Topcon TRC-NW400. 2212x1661. Patient age: 74 years. Central corneal thickness: 583 µm. Optic disc at the center of the field. FOV: 30 degrees. Retinal fundus photograph:
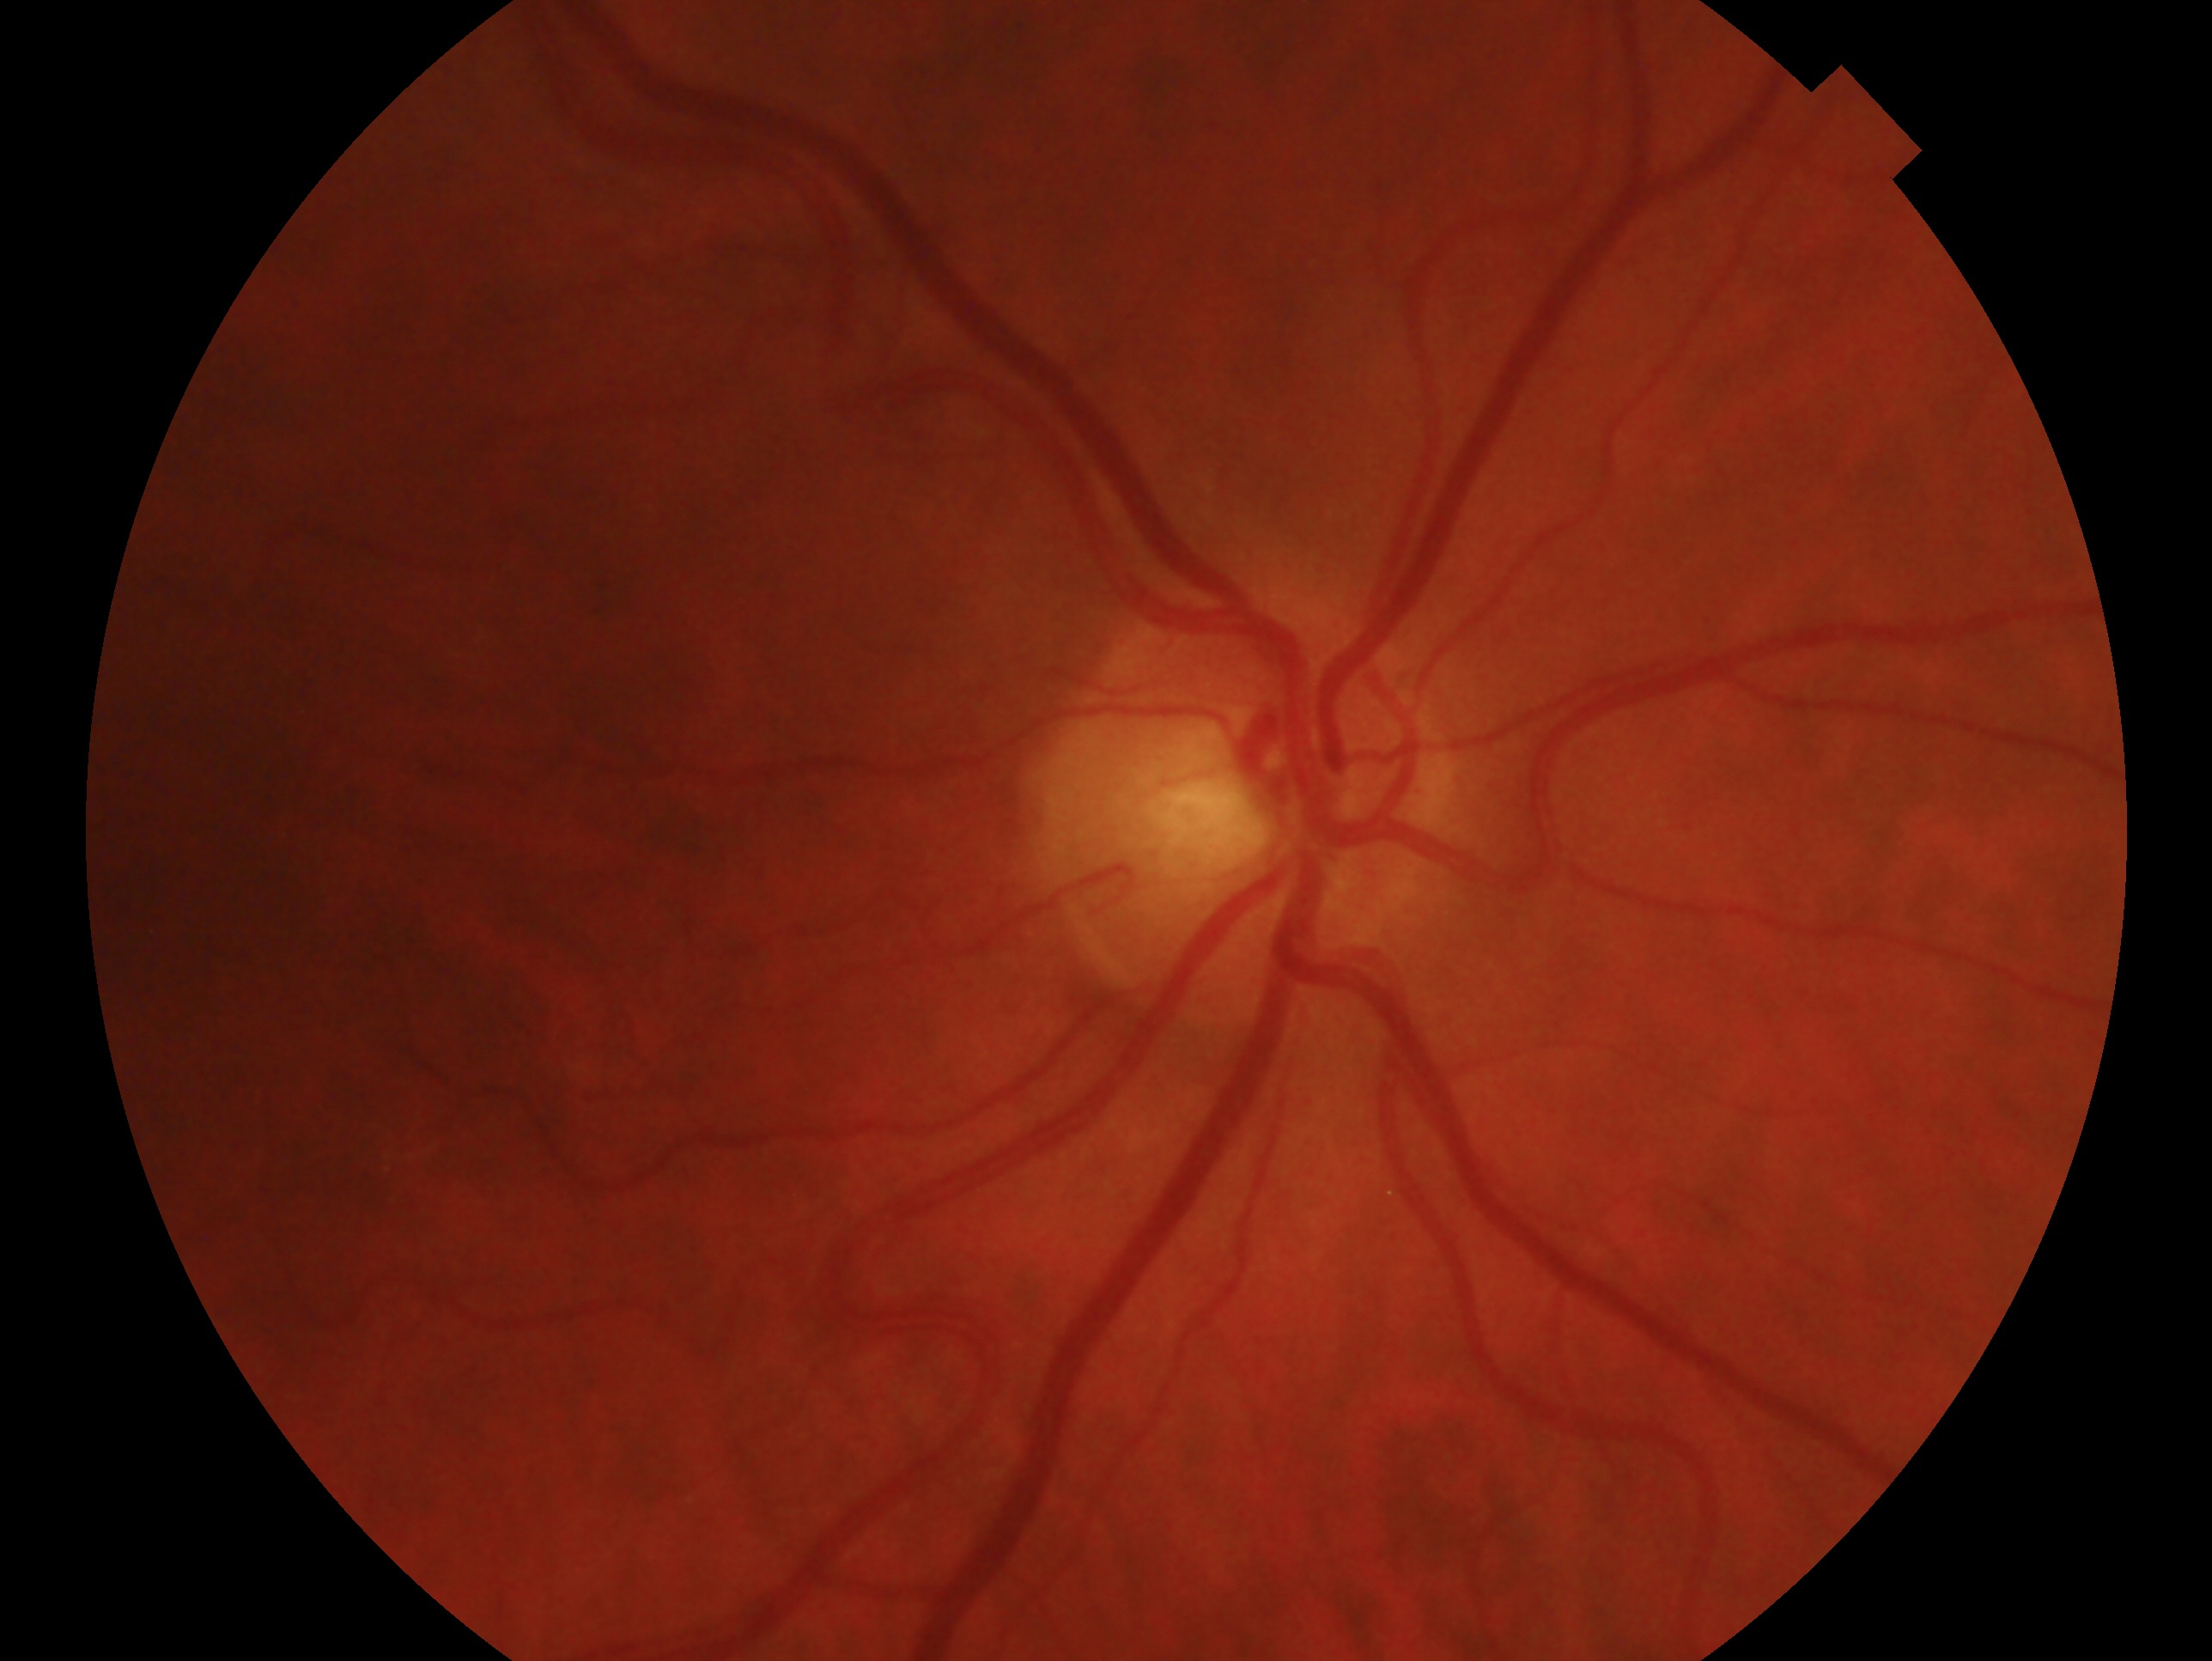 {
  "glaucoma_dx": "no signs of glaucoma",
  "eye": "right eye"
}